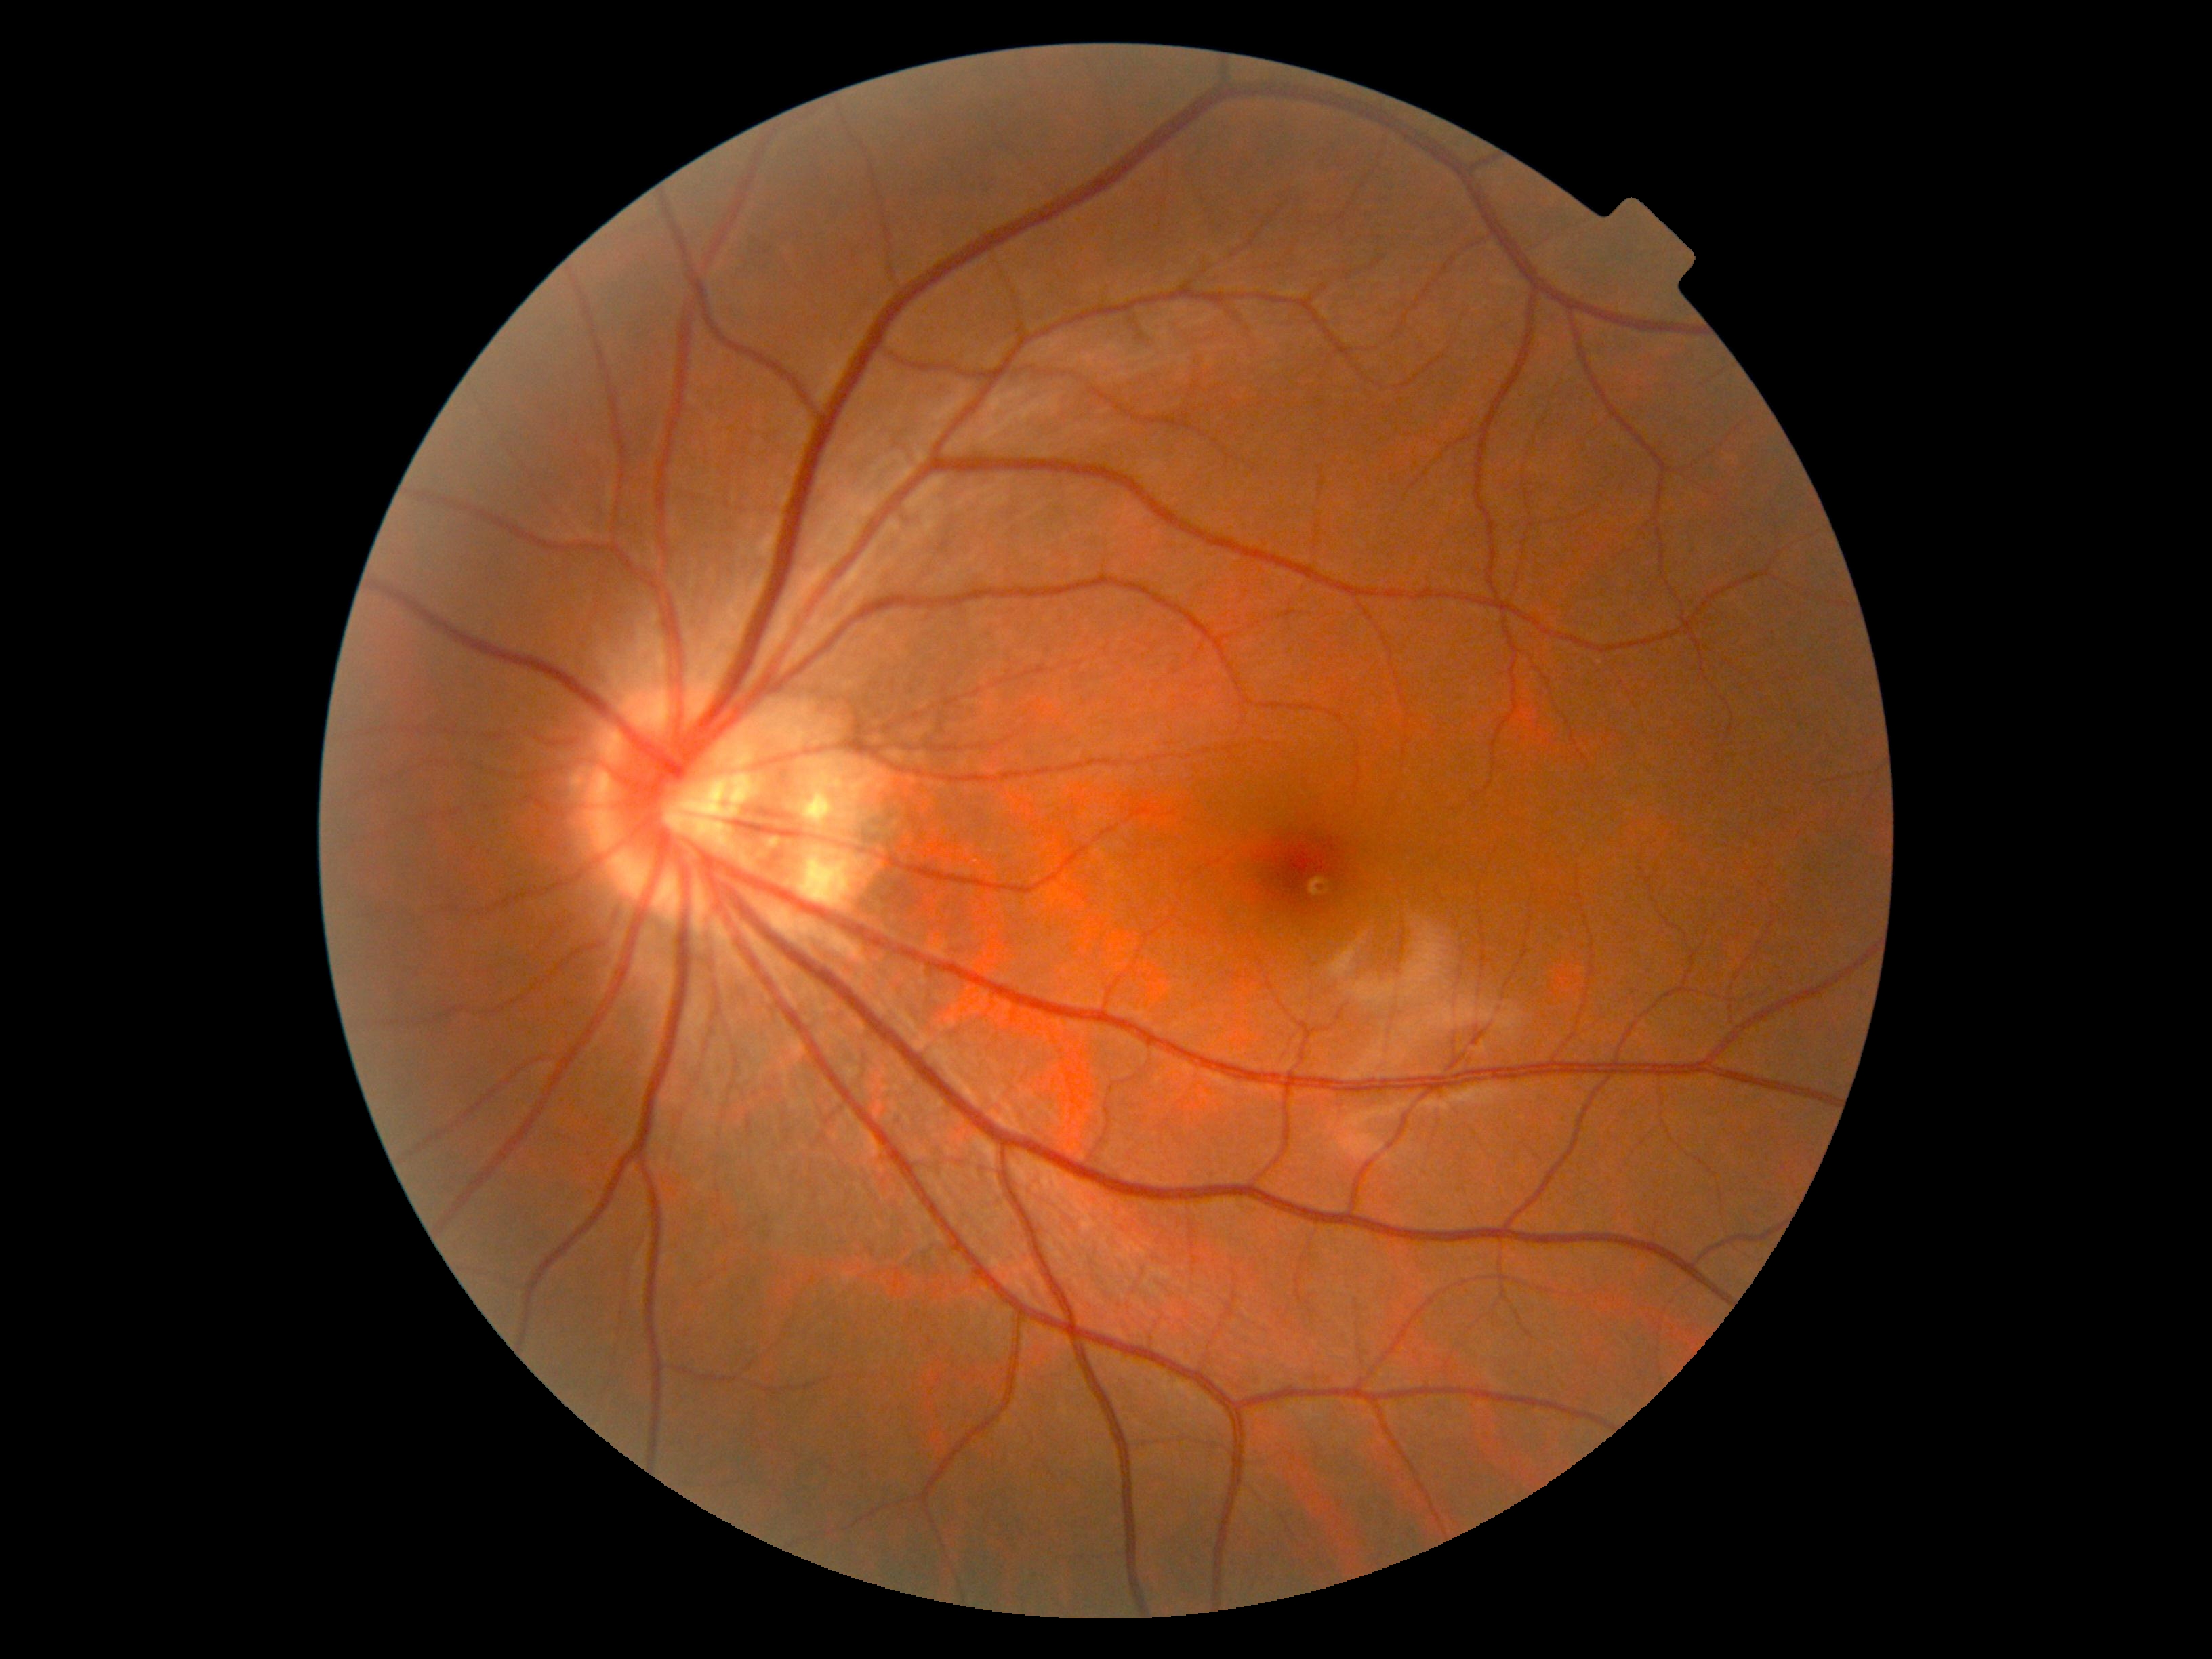 DR stage: grade 0 (no apparent retinopathy).